Without pupil dilation, 45-degree field of view.
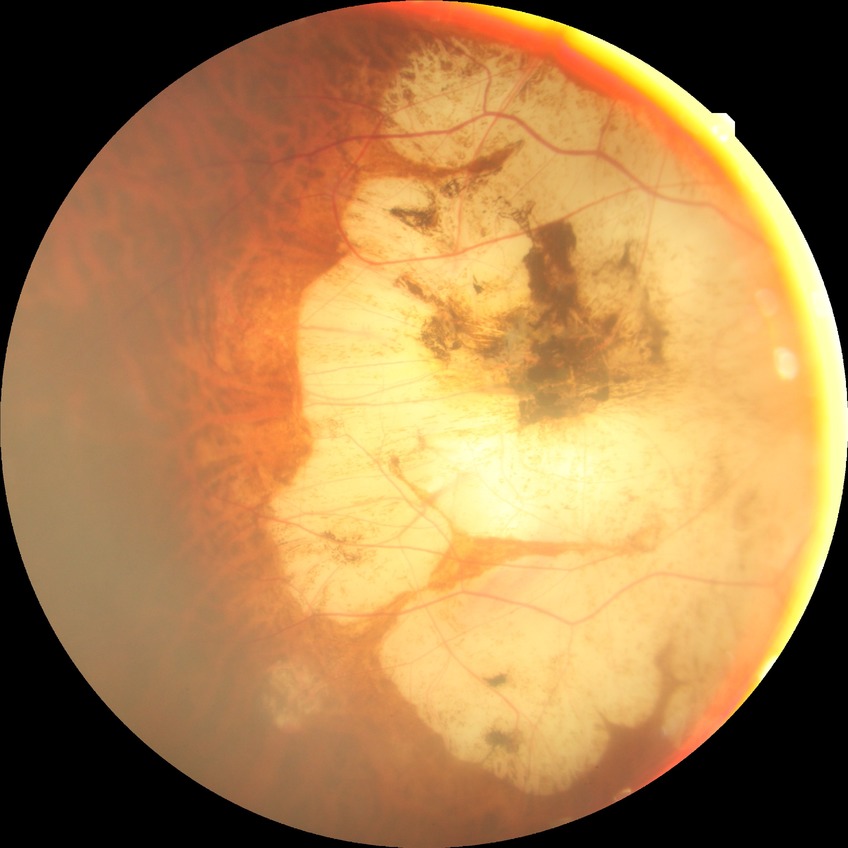
Assessment:
- DR severity: NDR